45° FOV, 1380x1382
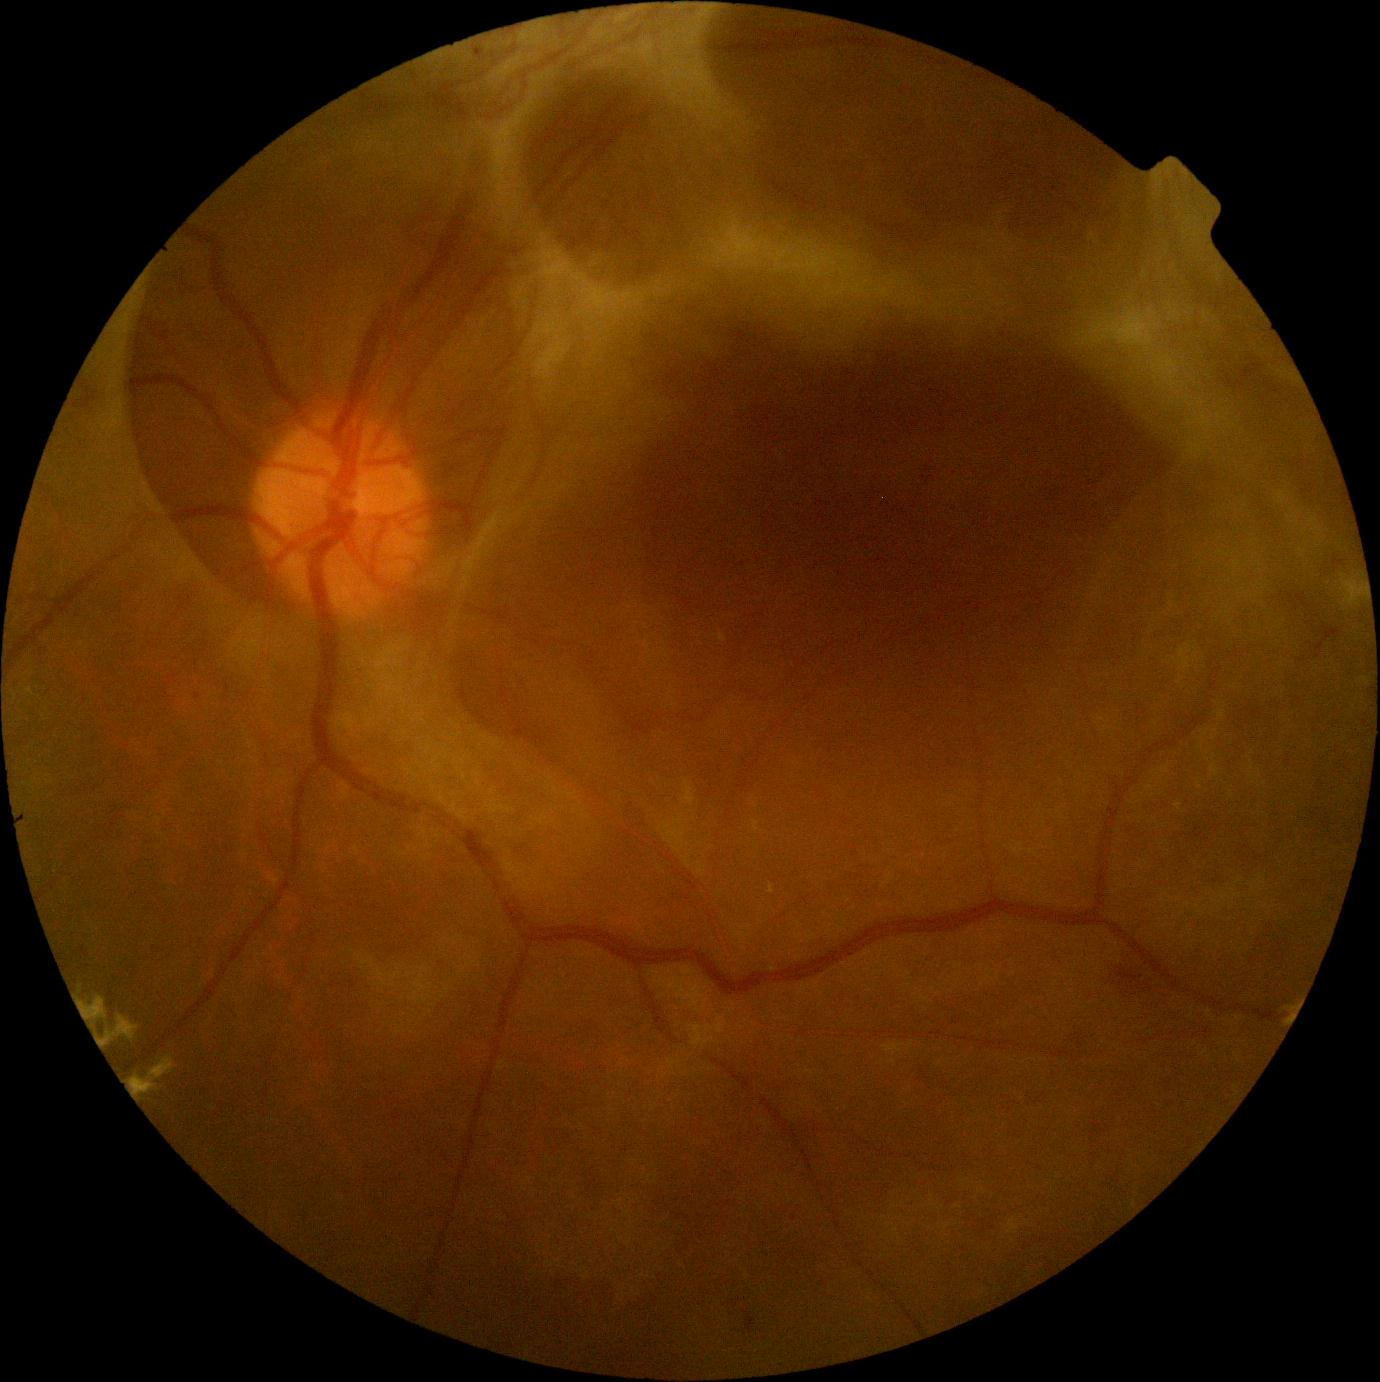 DR grade: PDR (4).